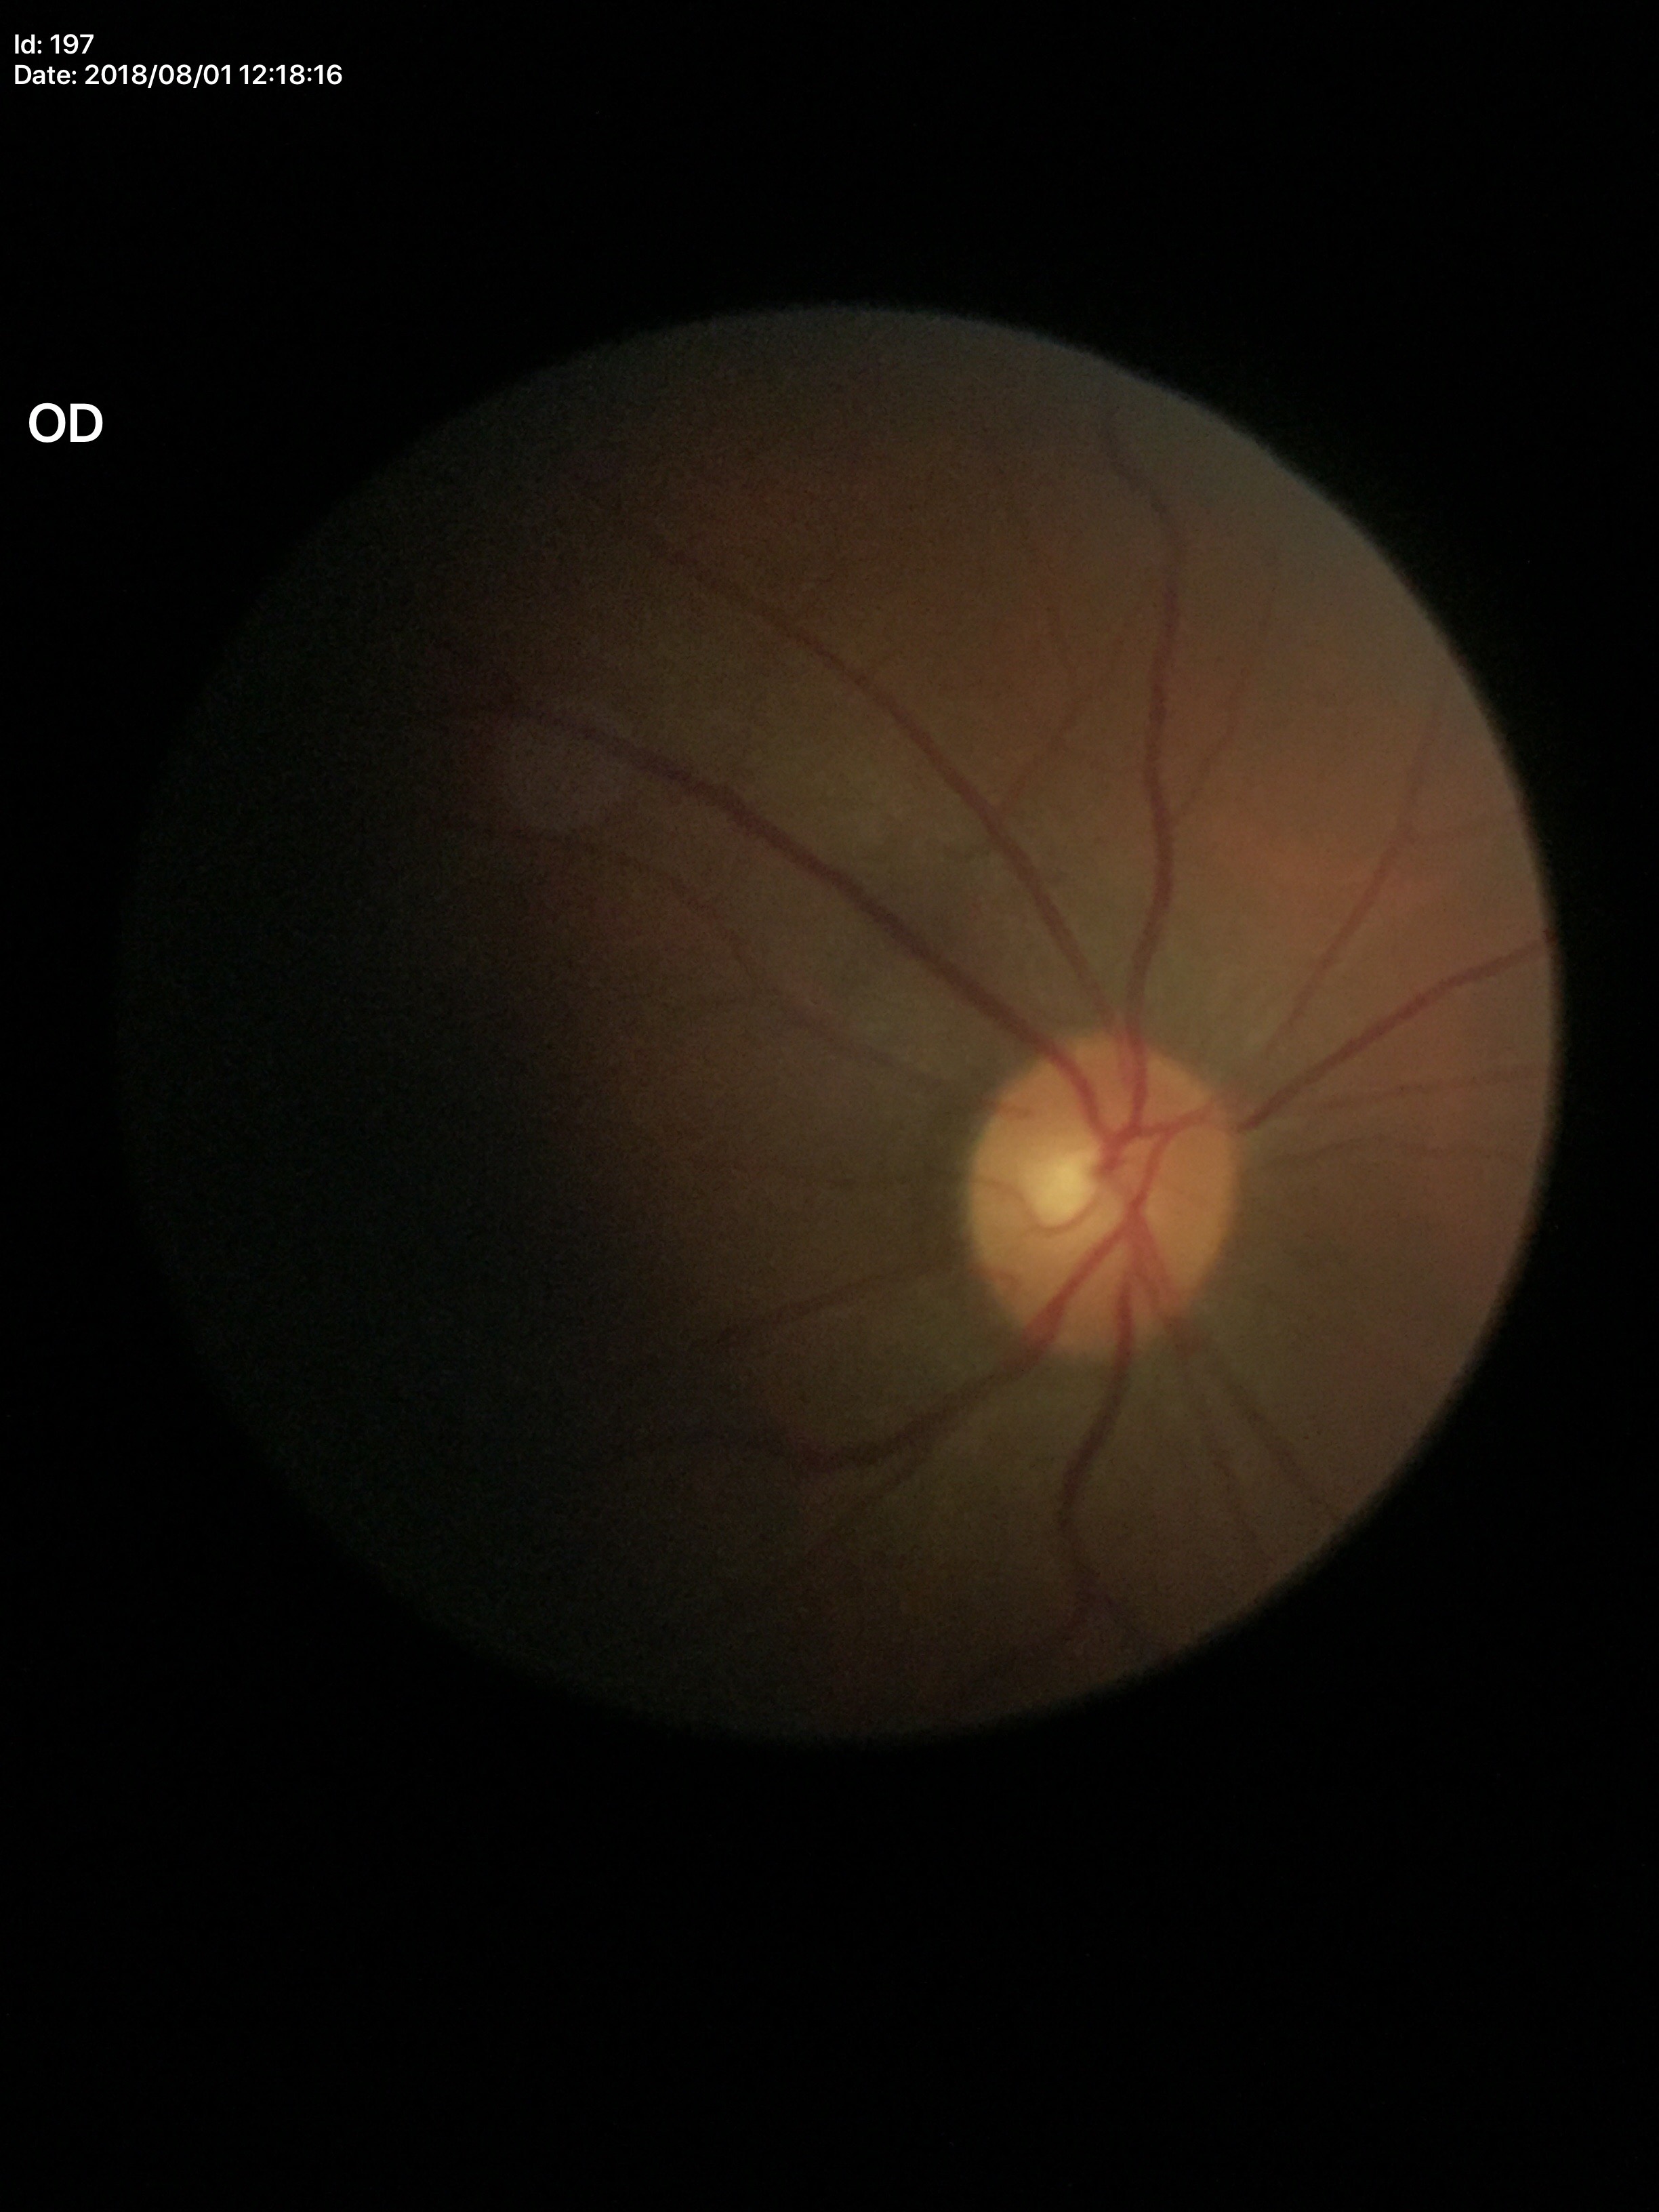
Glaucoma decision = not suspect (all 5 graders called normal) | VCDR = 0.52.